CFP. FOV: 45 degrees: 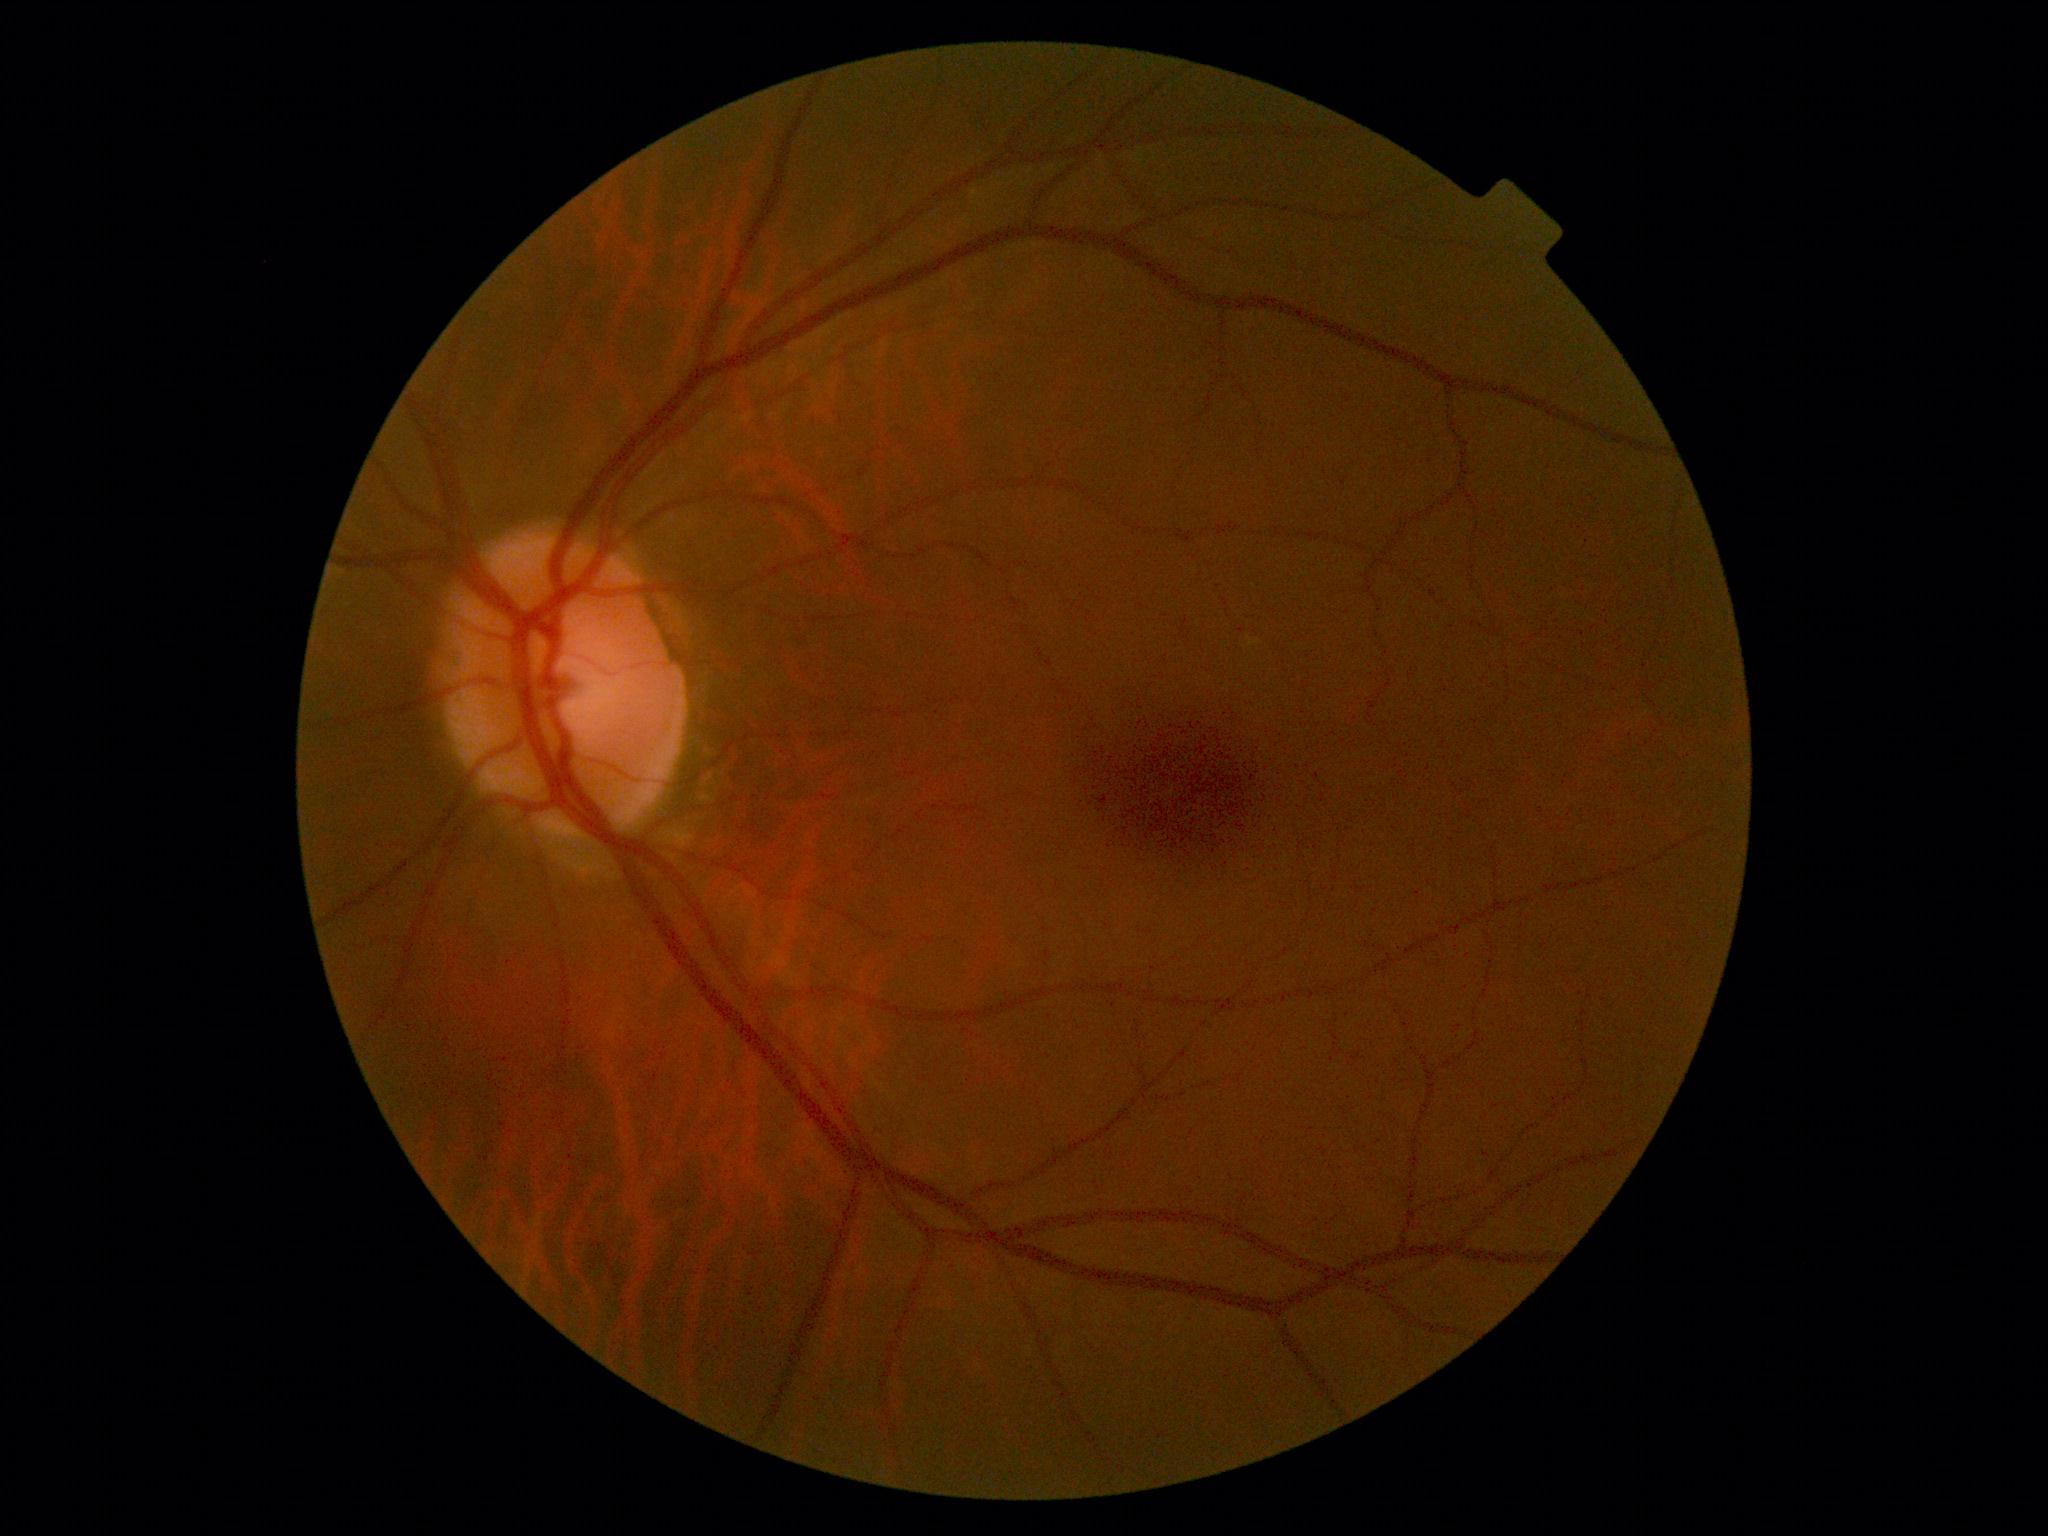

retinopathy@no apparent diabetic retinopathy (grade 0).